Pediatric wide-field fundus photograph:
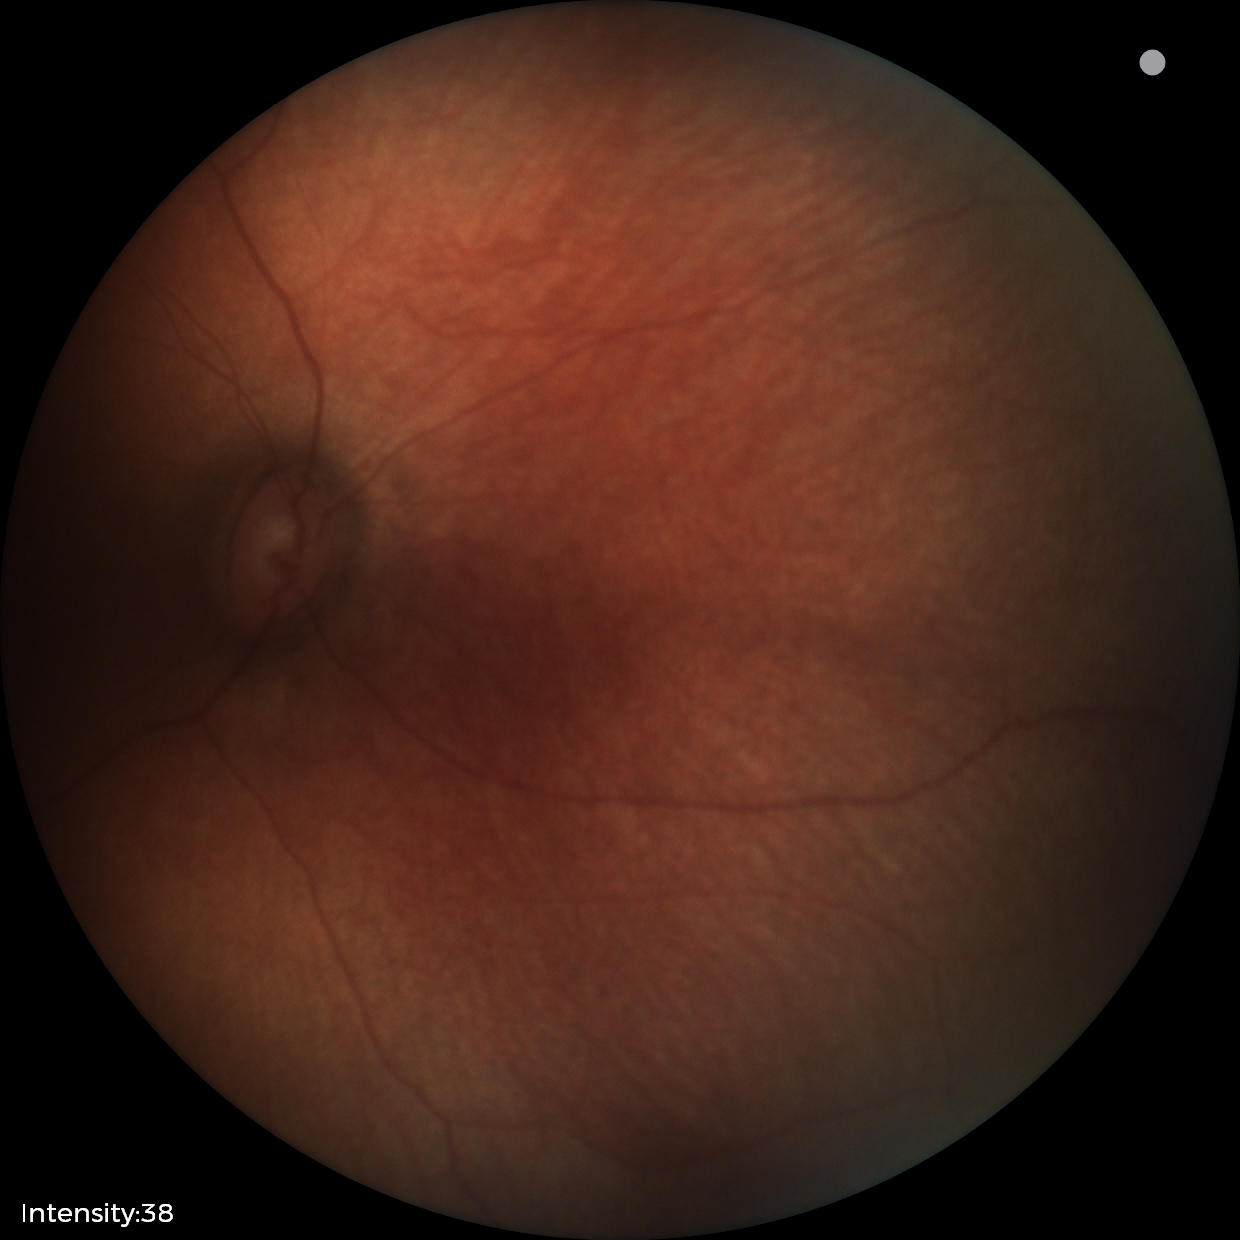

Screening examination with no abnormal retinal findings.